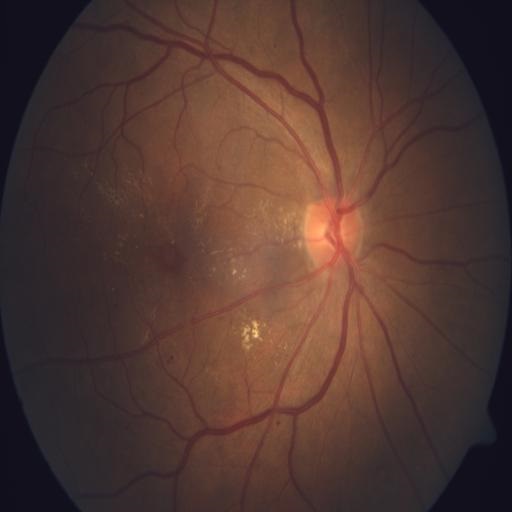

2 abnormalities. Showing exudation (EDN) and microaneurysms (MCA).